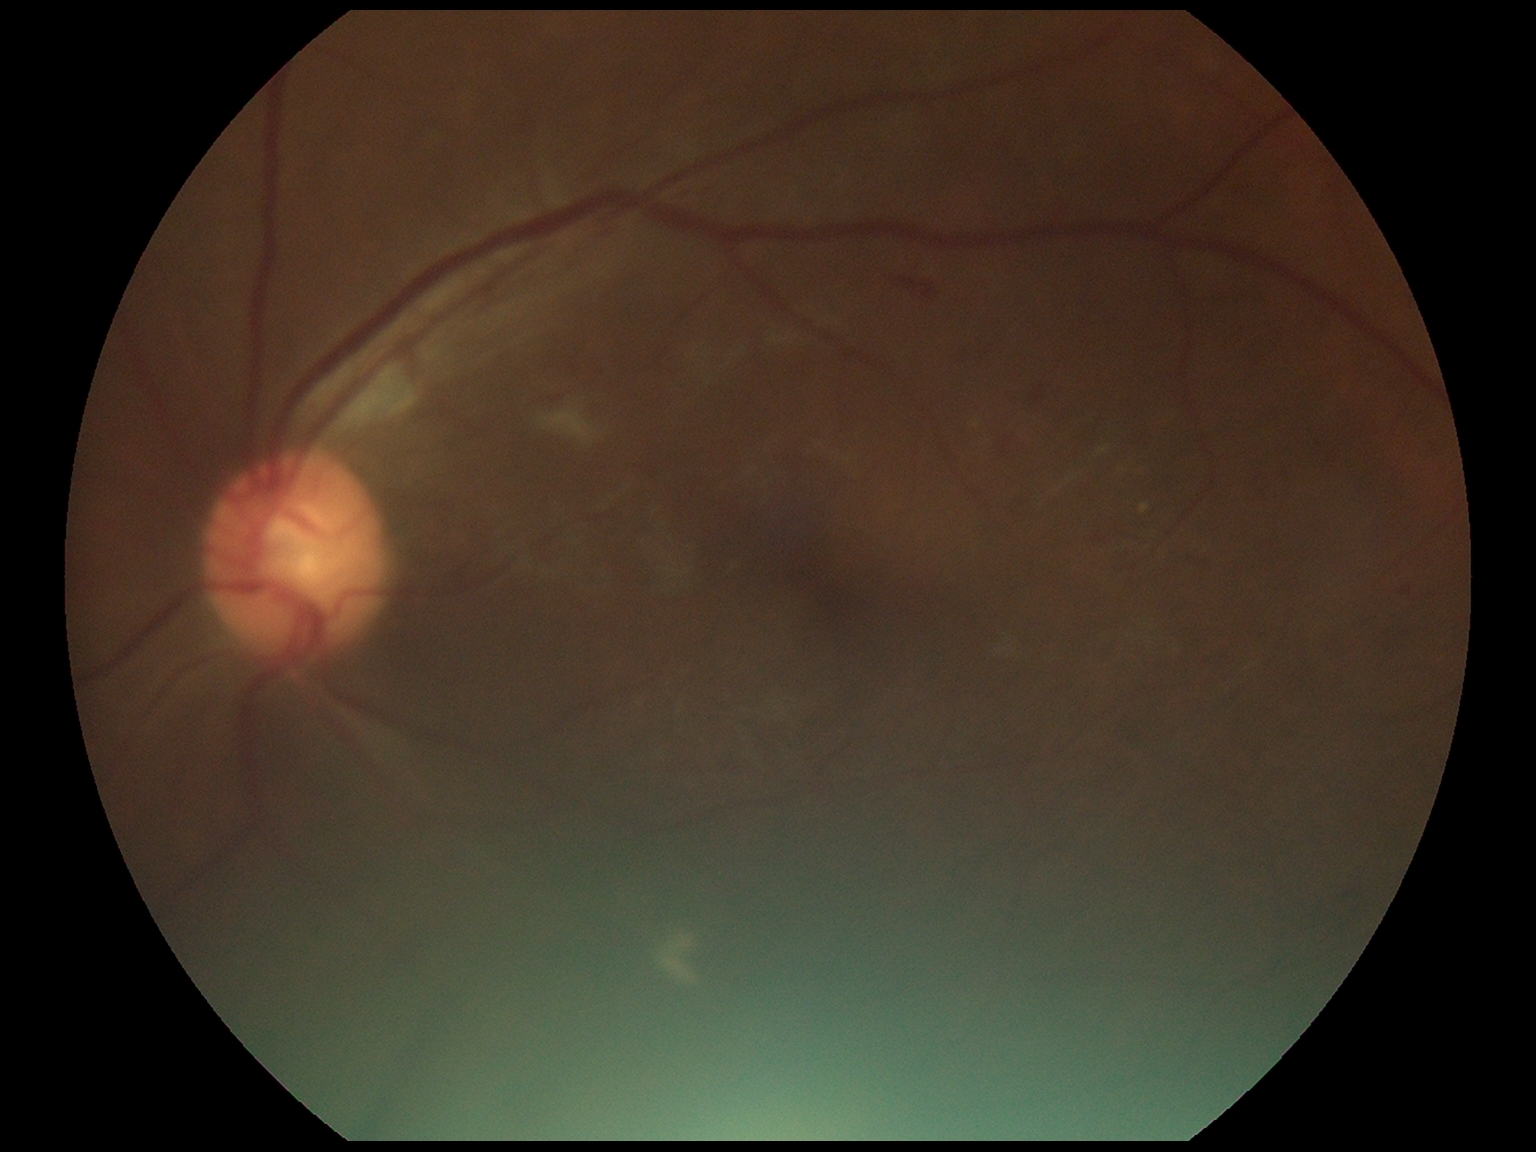 Diabetic retinopathy (DR) is grade 2 — more than just microaneurysms but less than severe NPDR.